100° field of view (Phoenix ICON). Phoenix ICON wide-field infant fundus image: 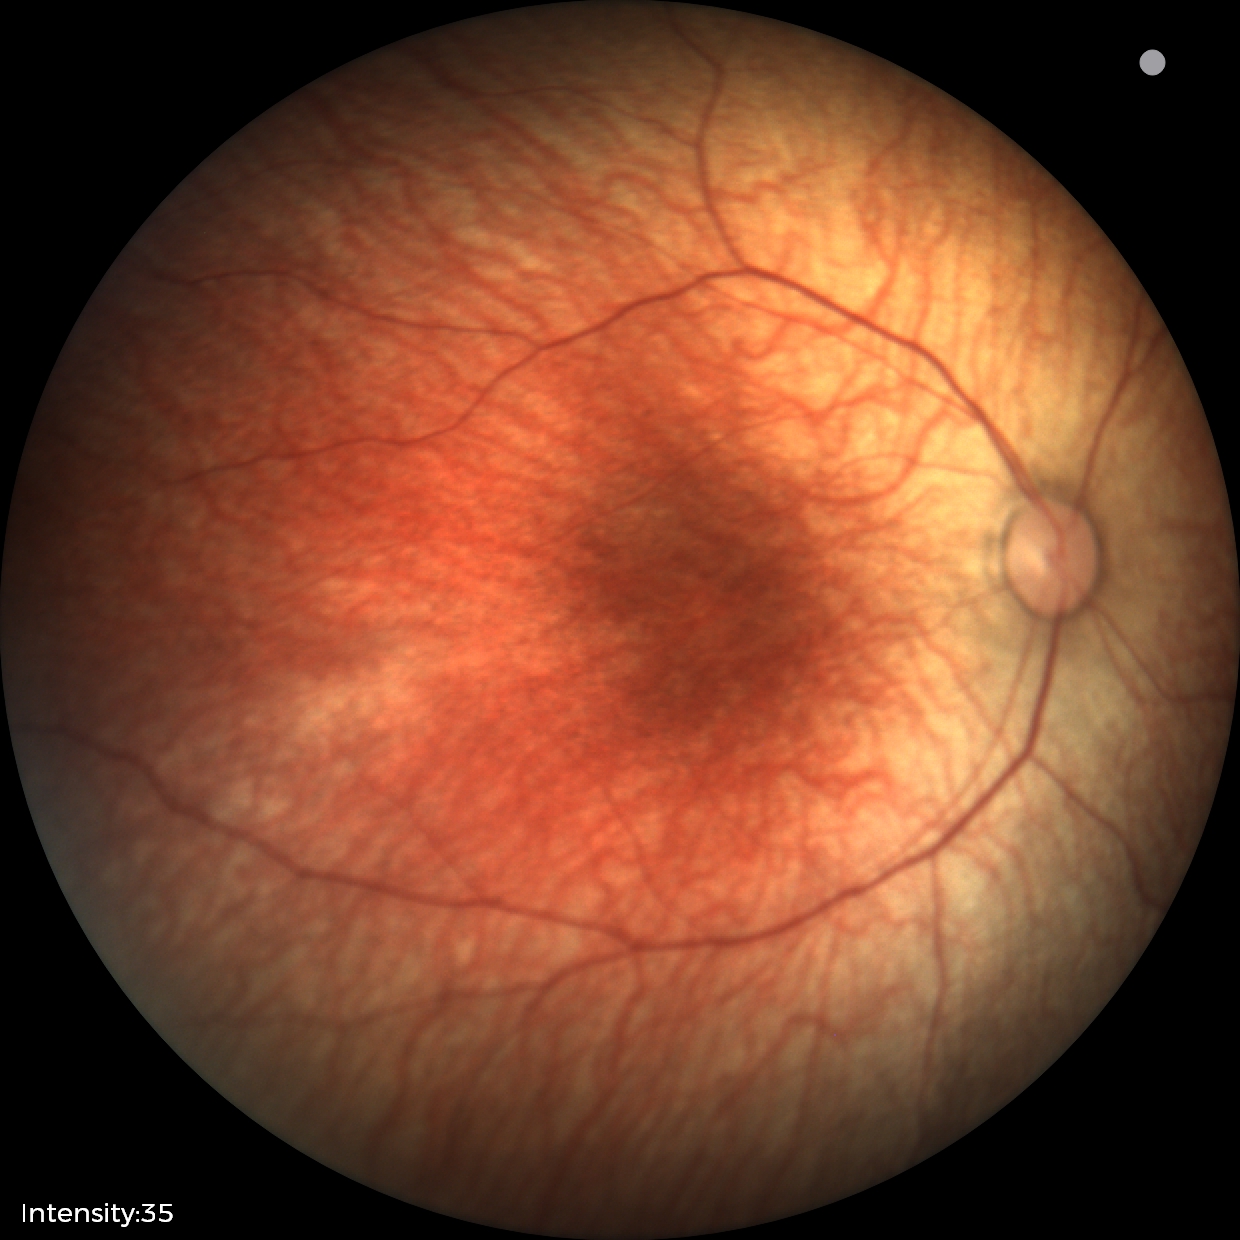
Physiological retinal appearance for postconceptual age.